Diabetic retinopathy graded by the modified Davis classification.
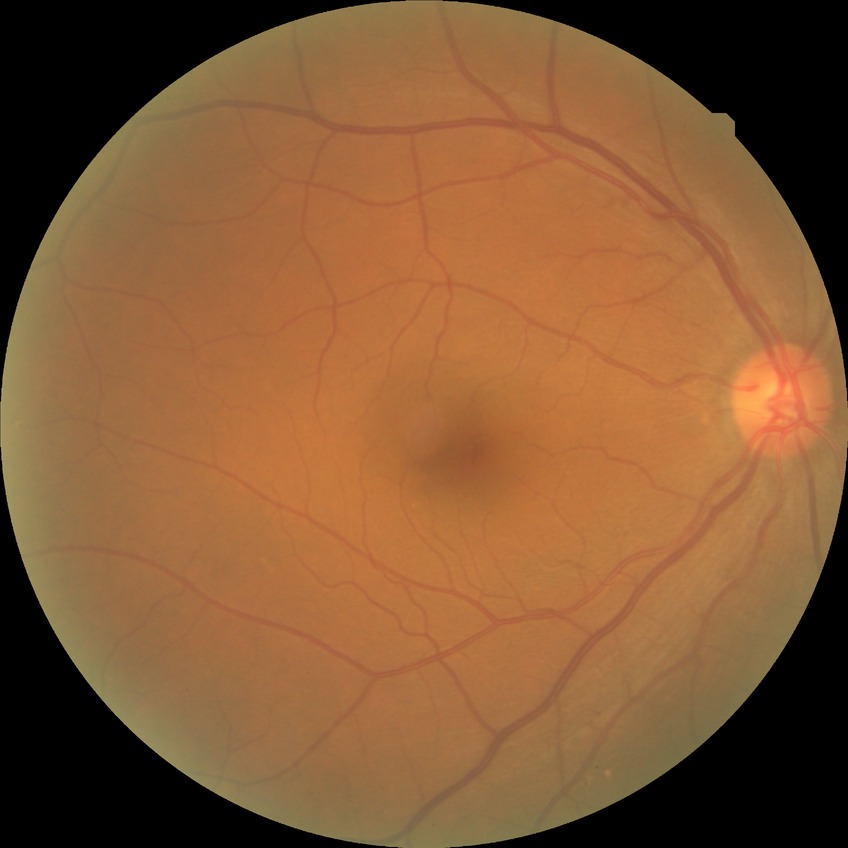

diabetic retinopathy (DR): NDR (no diabetic retinopathy).